Color fundus photograph · 45° FOV:
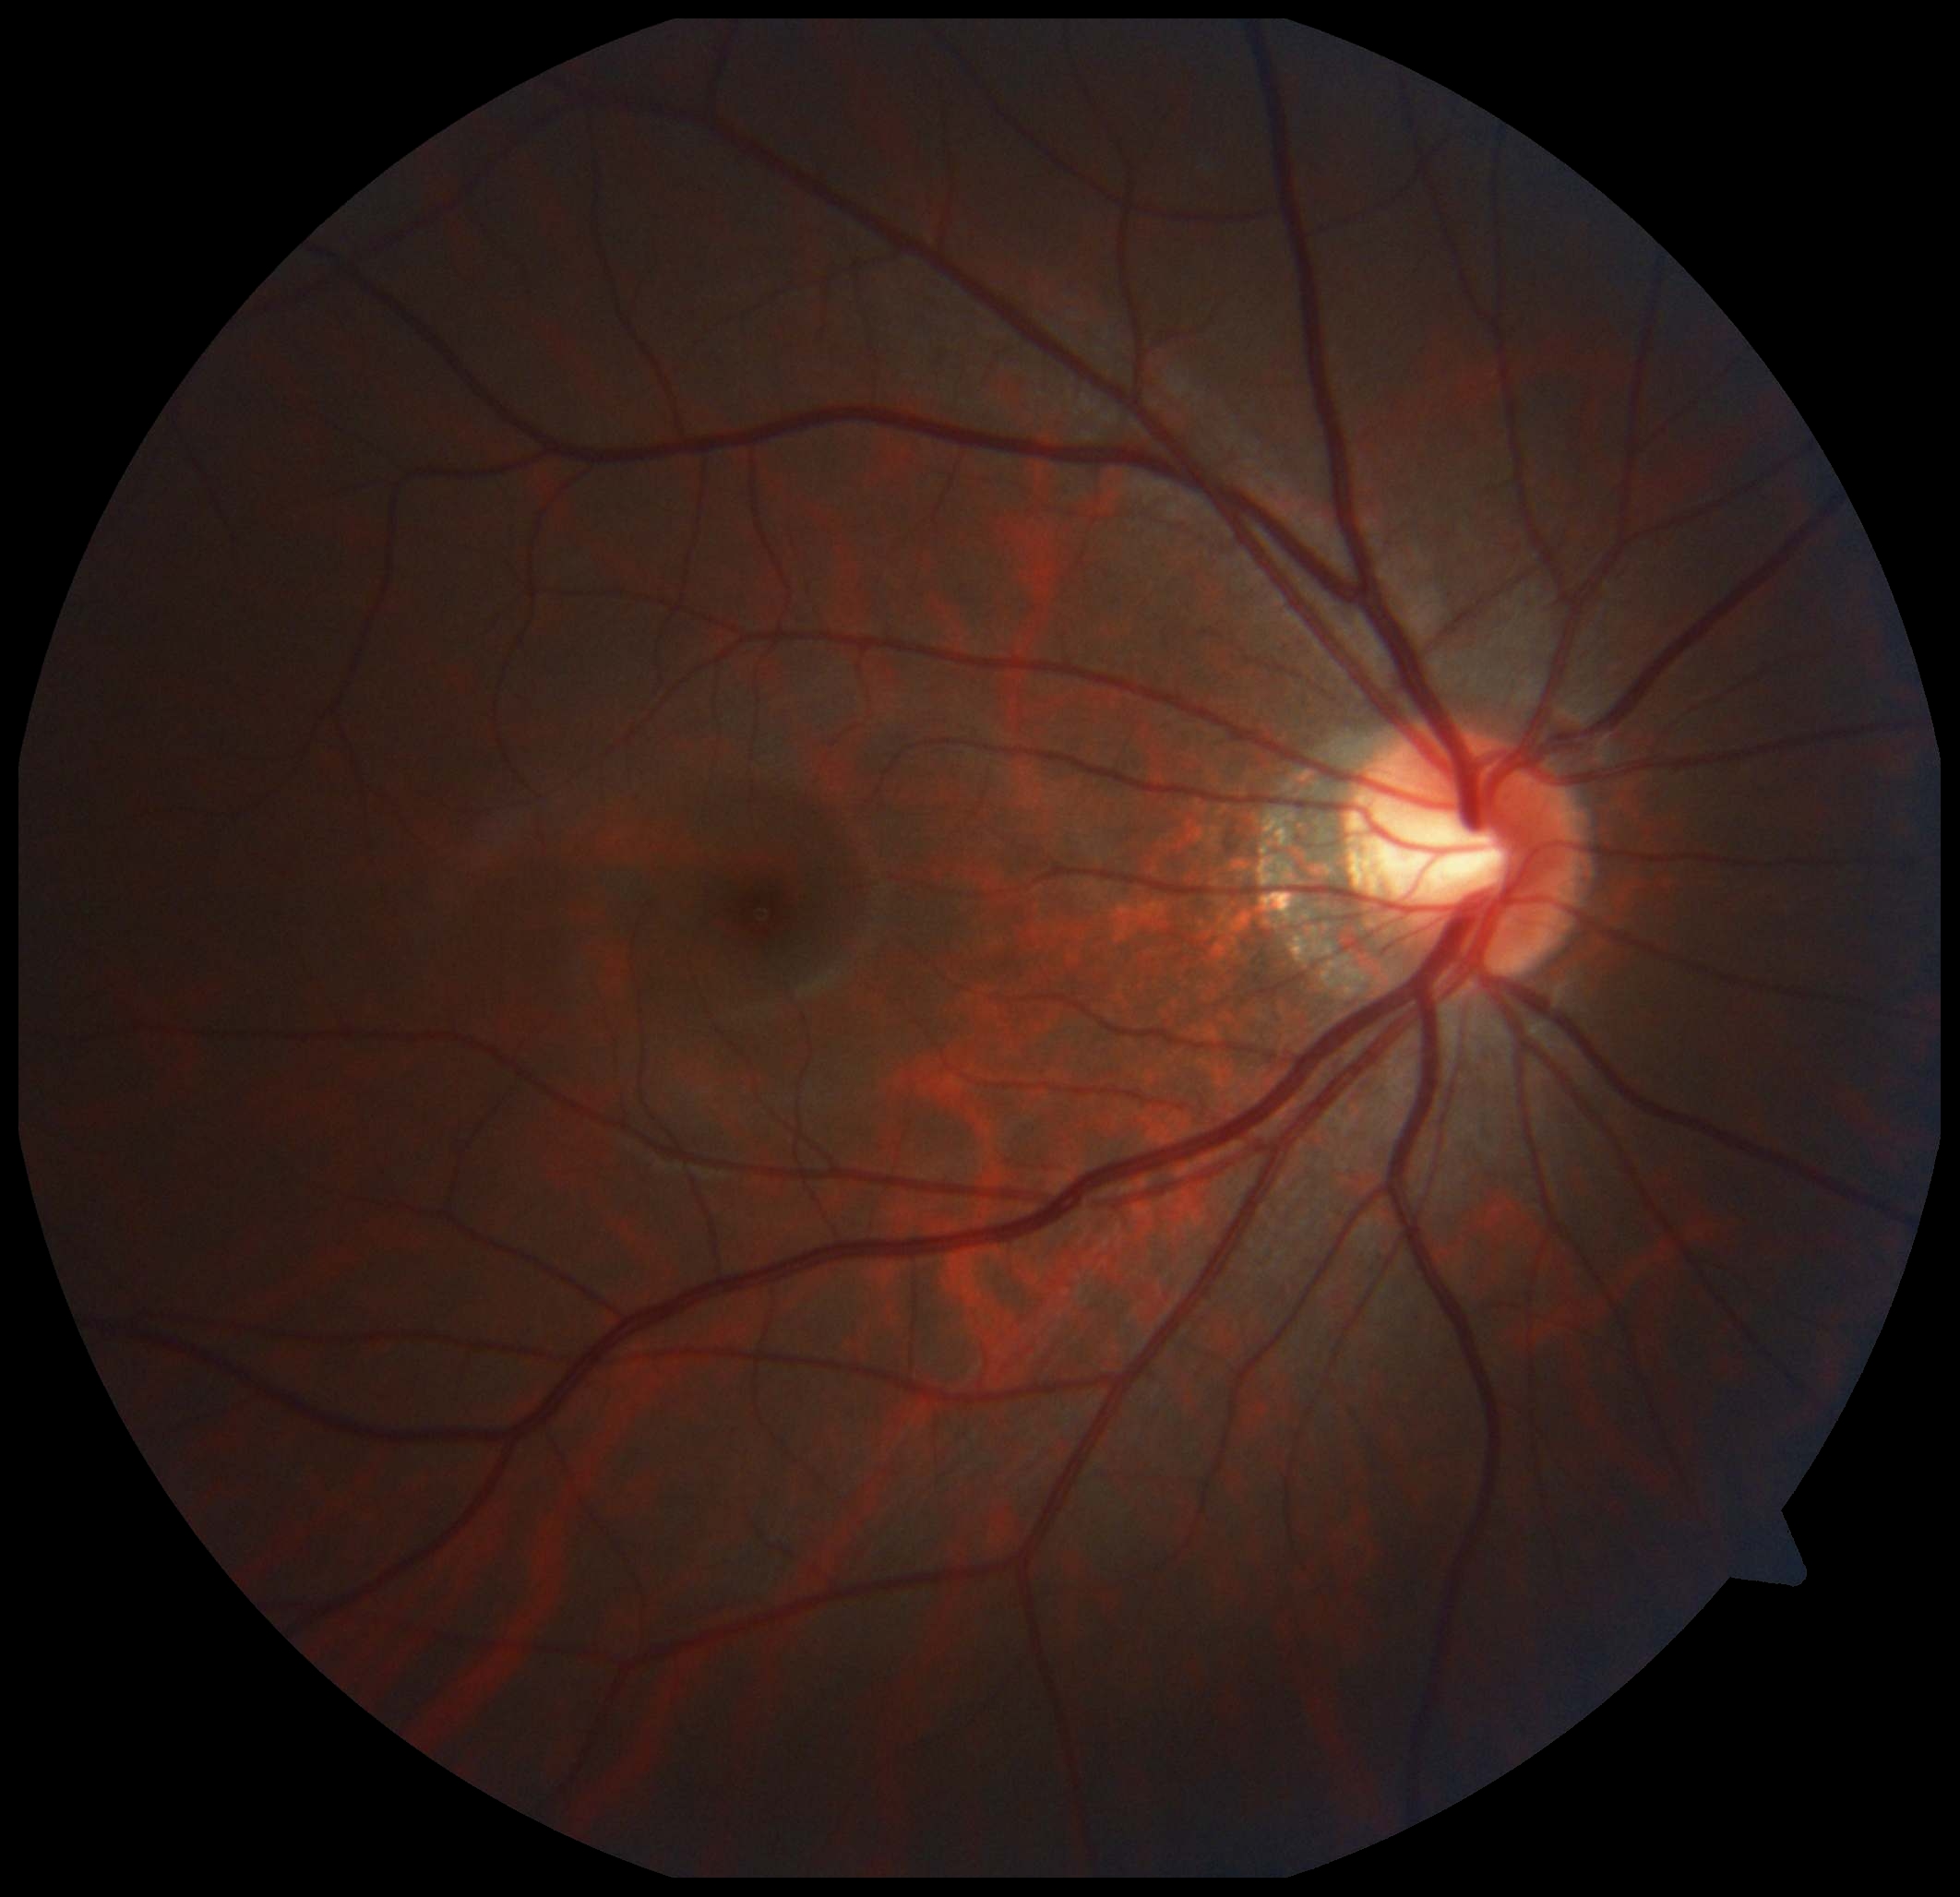 dr_grade: grade 0